Without pupil dilation: 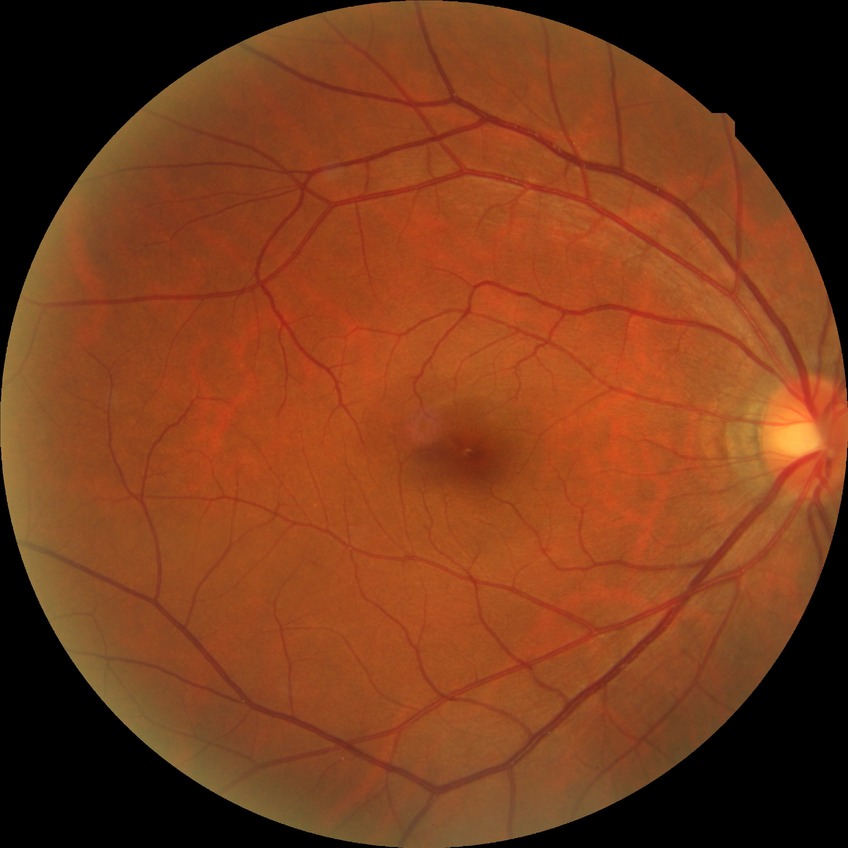
Diabetic retinopathy severity: no diabetic retinopathy.